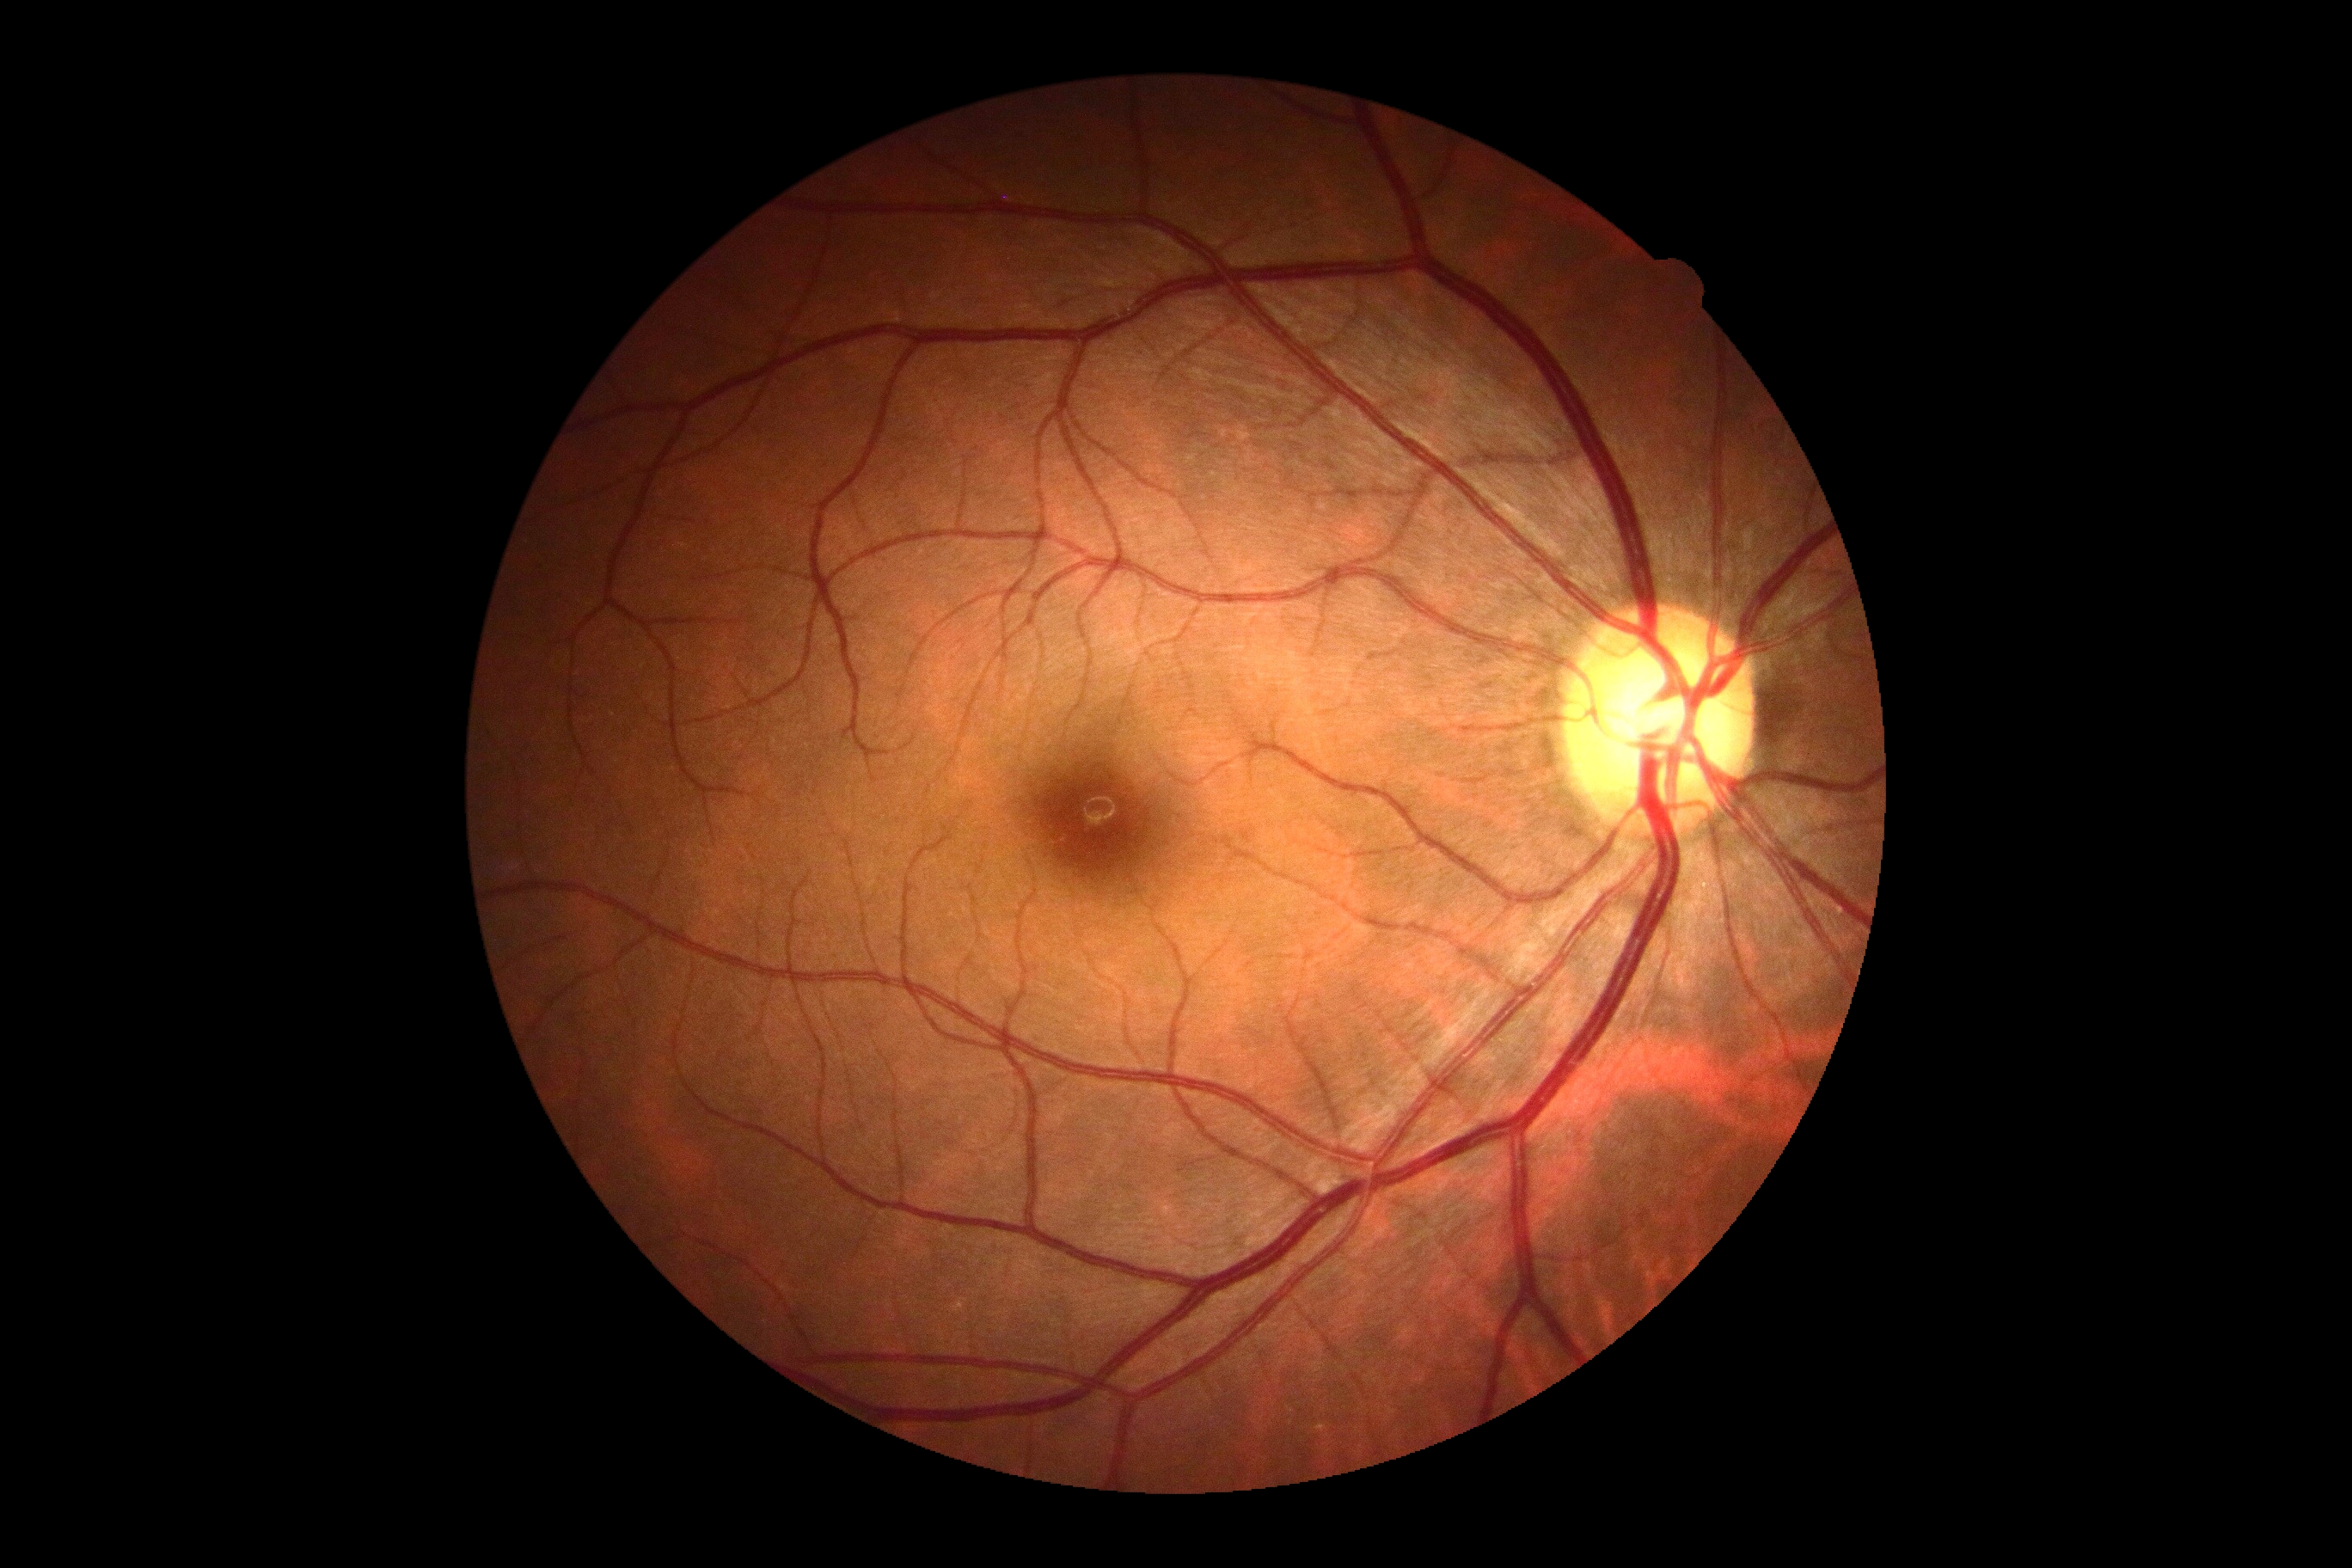 DR is no apparent diabetic retinopathy (grade 0).